45° FOV.
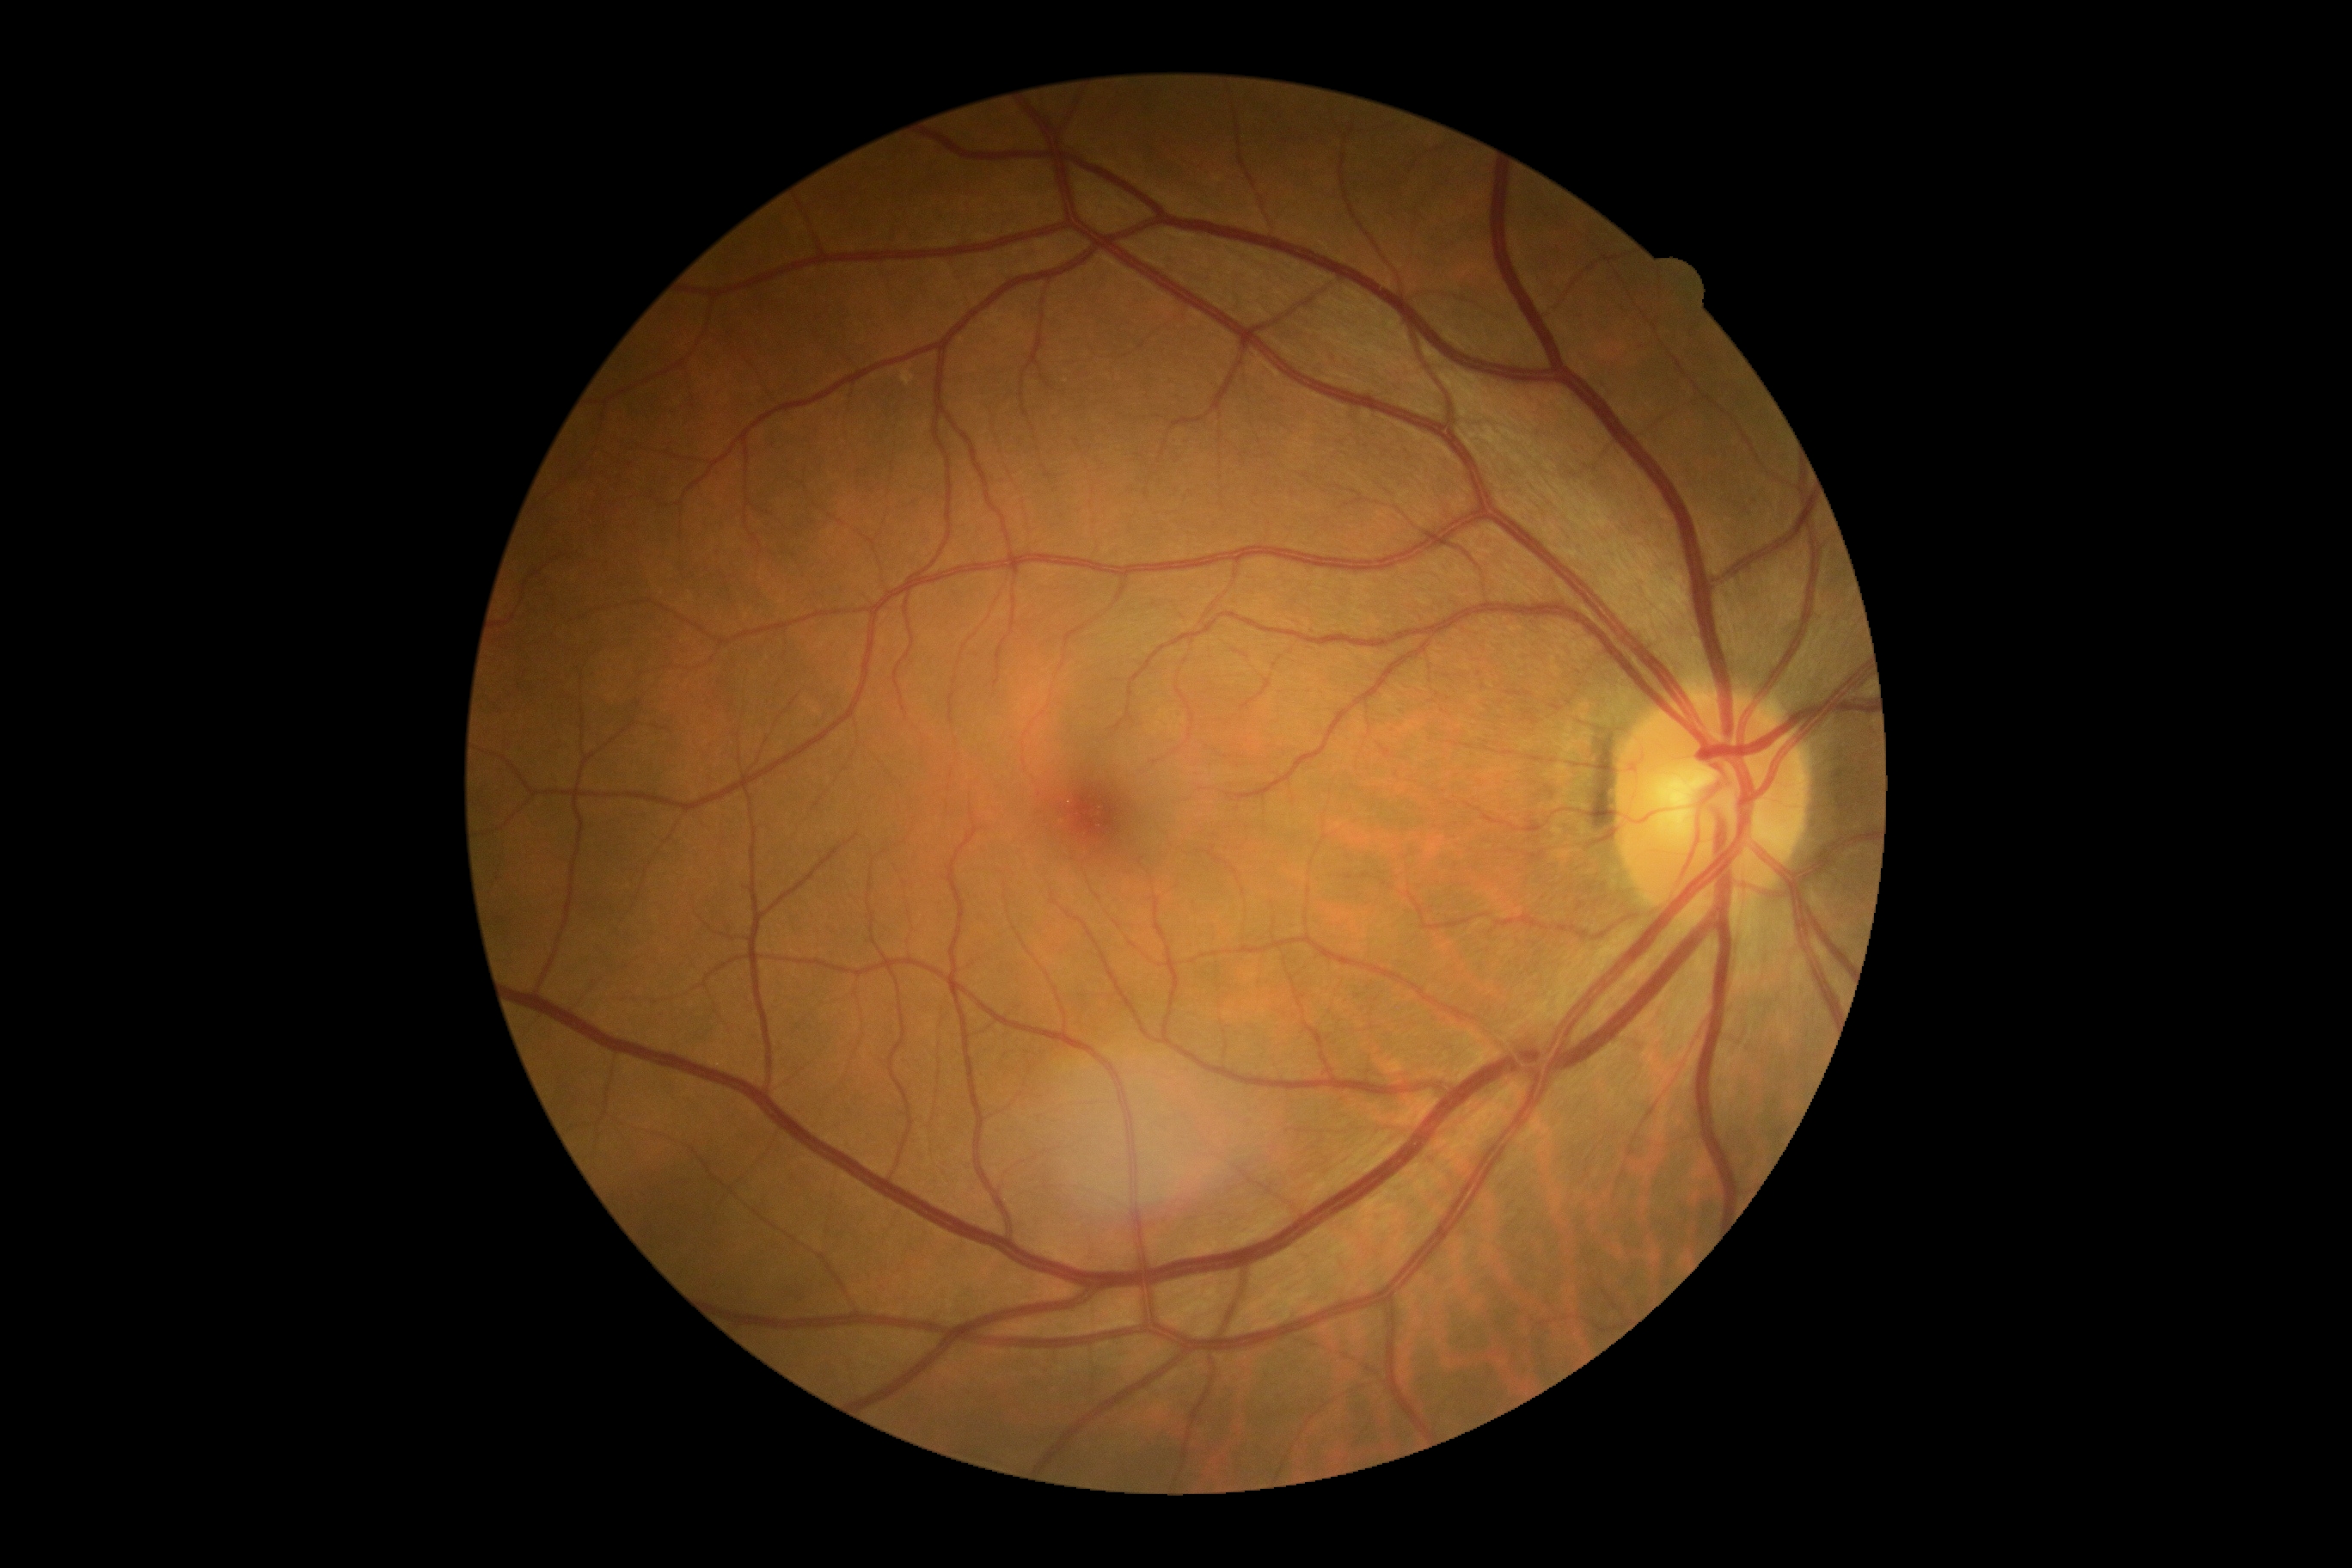
DR: 0.
No diabetic retinal disease findings.